Modified Davis classification.
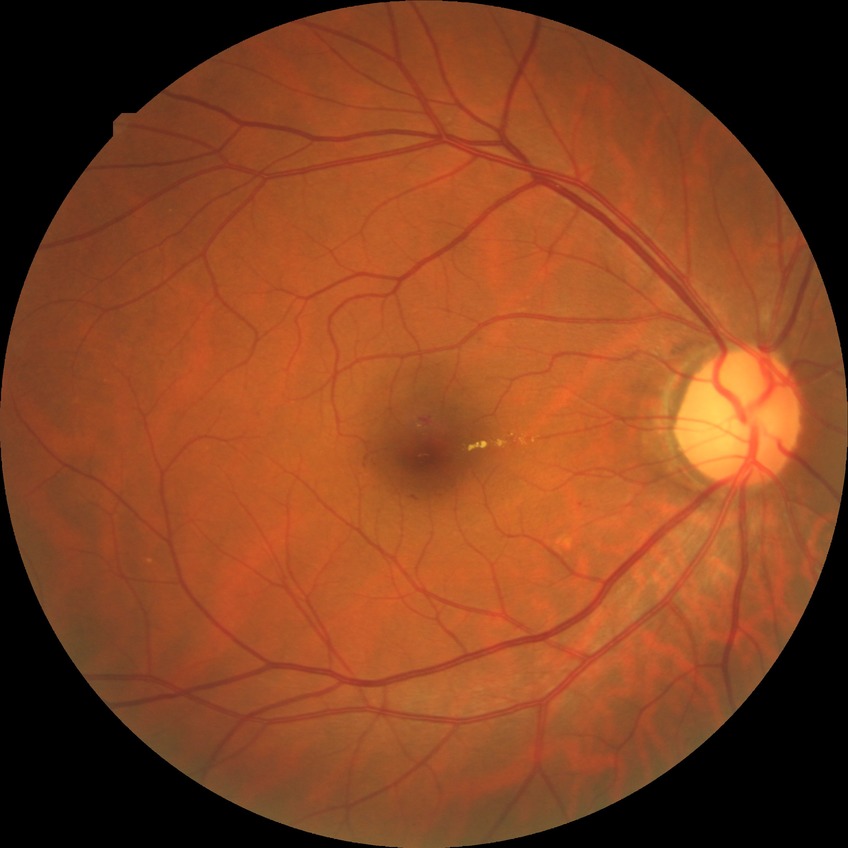 {
  "davis_grade": "simple diabetic retinopathy"
}